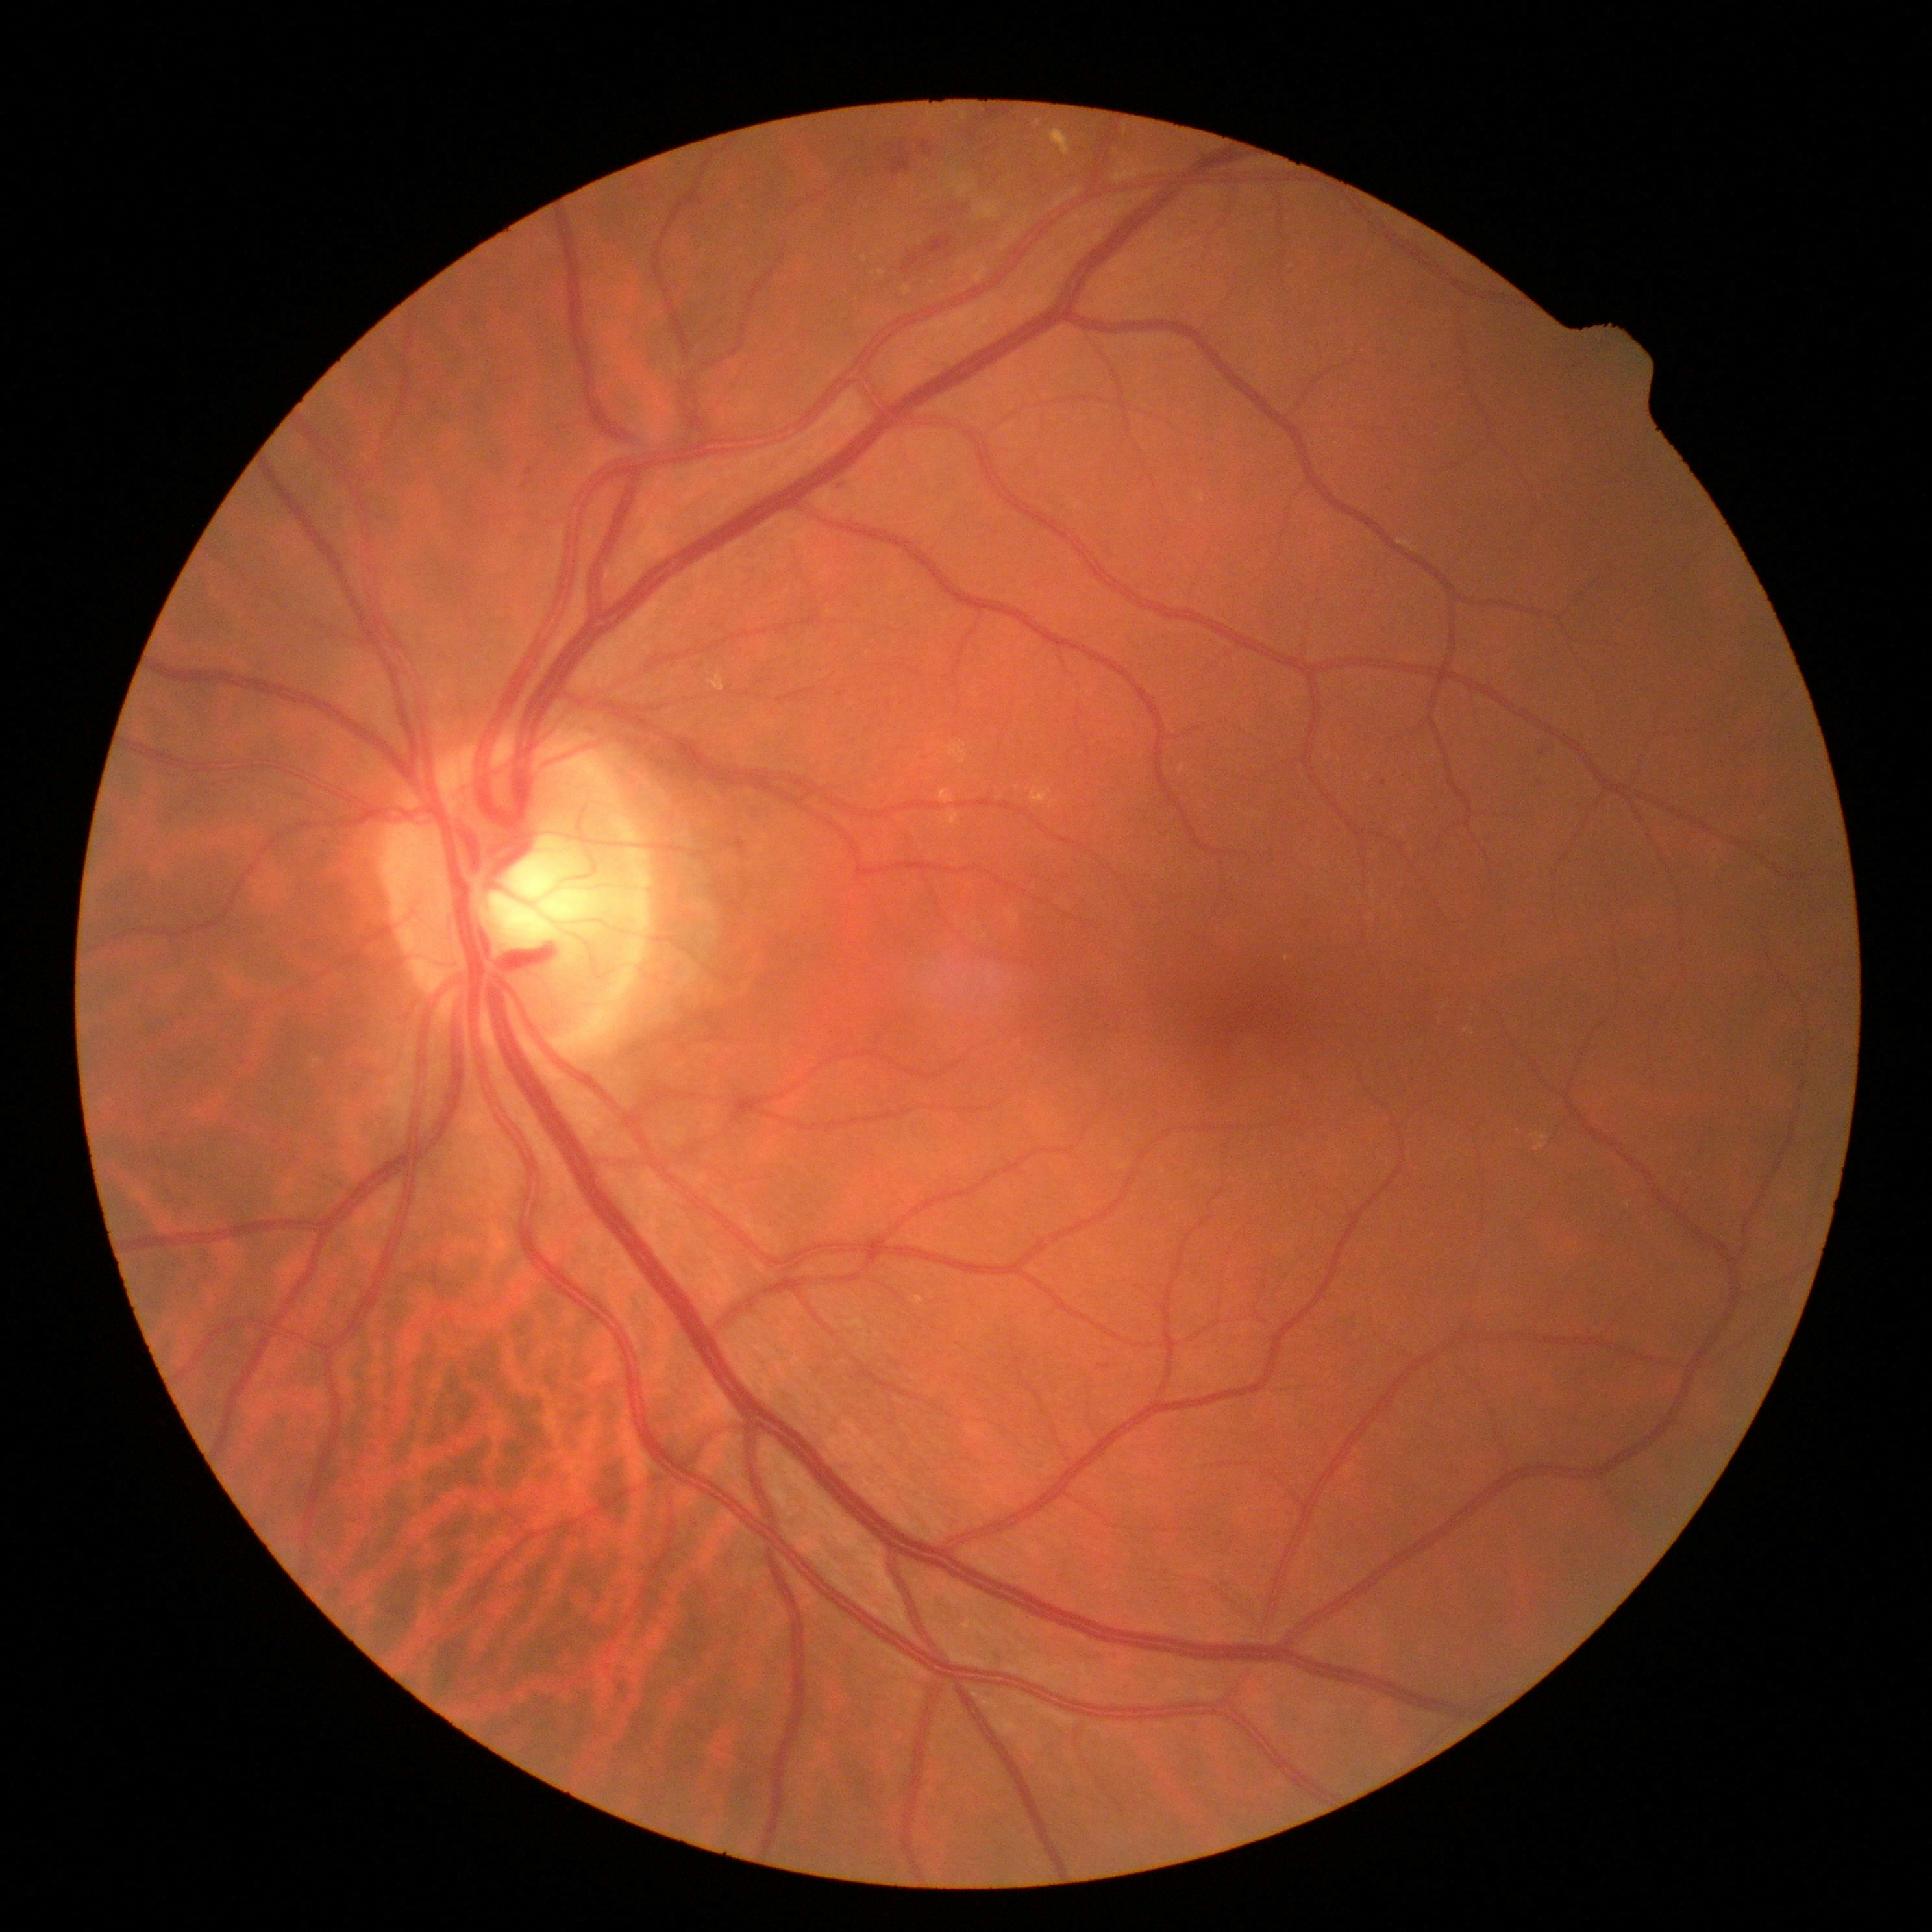 retinopathy: moderate NPDR (grade 2).